2048x1536 · camera: Forus 3Nethra fundus camera.
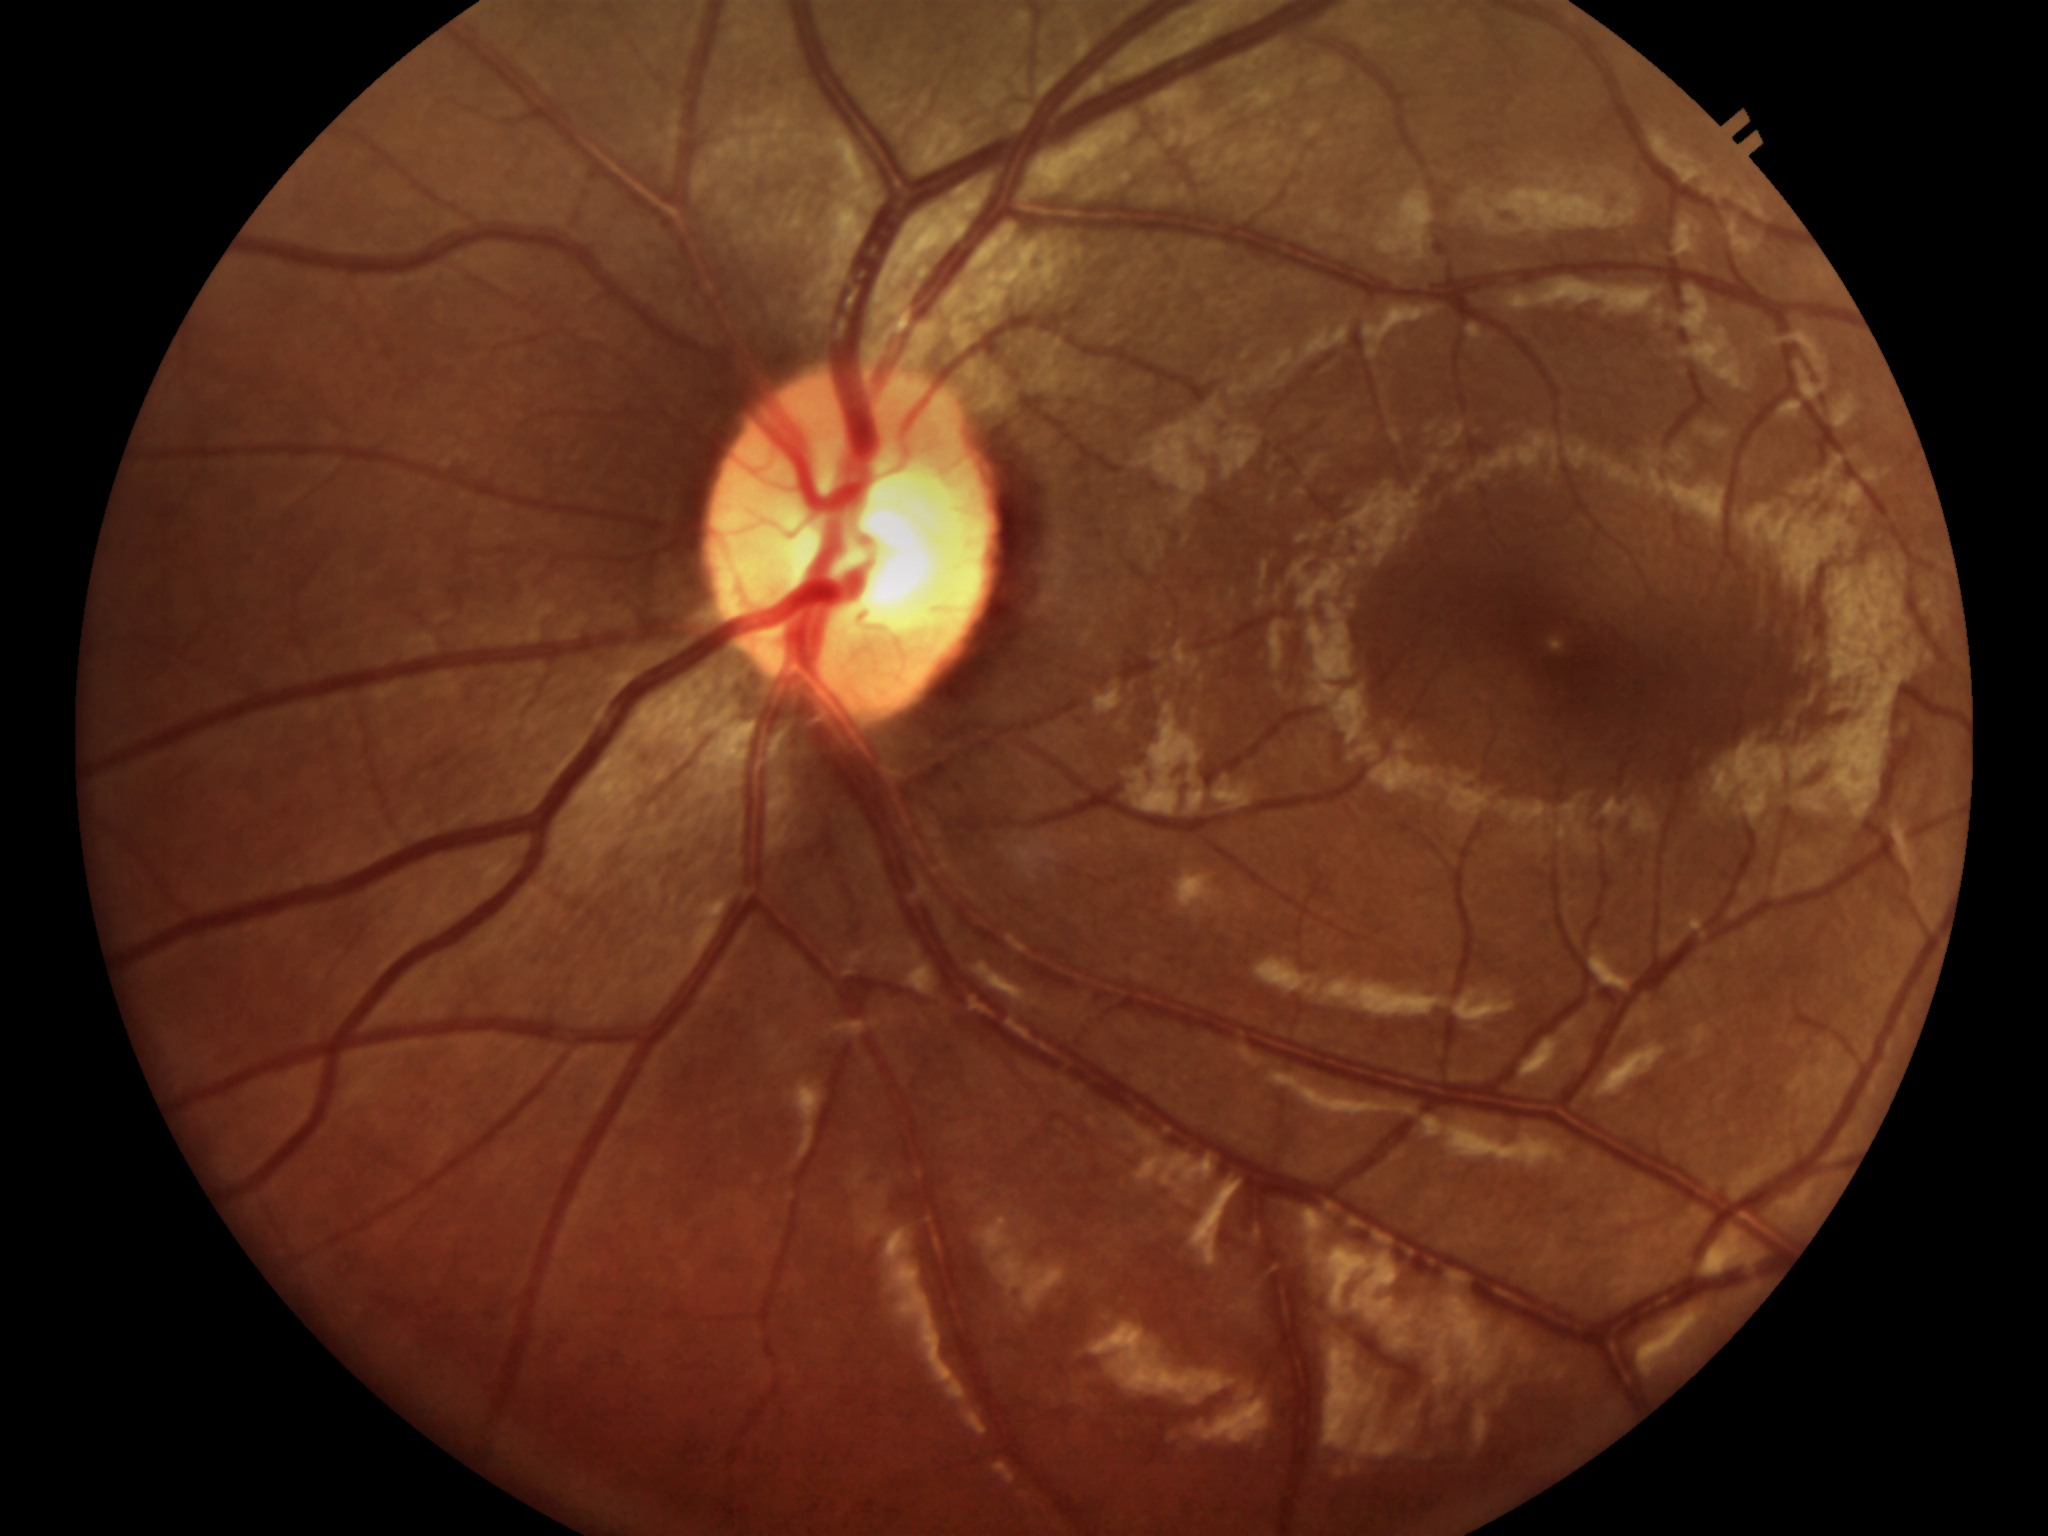
Not suspicious for glaucoma. Vertical cup-to-disc ratio of 0.51.